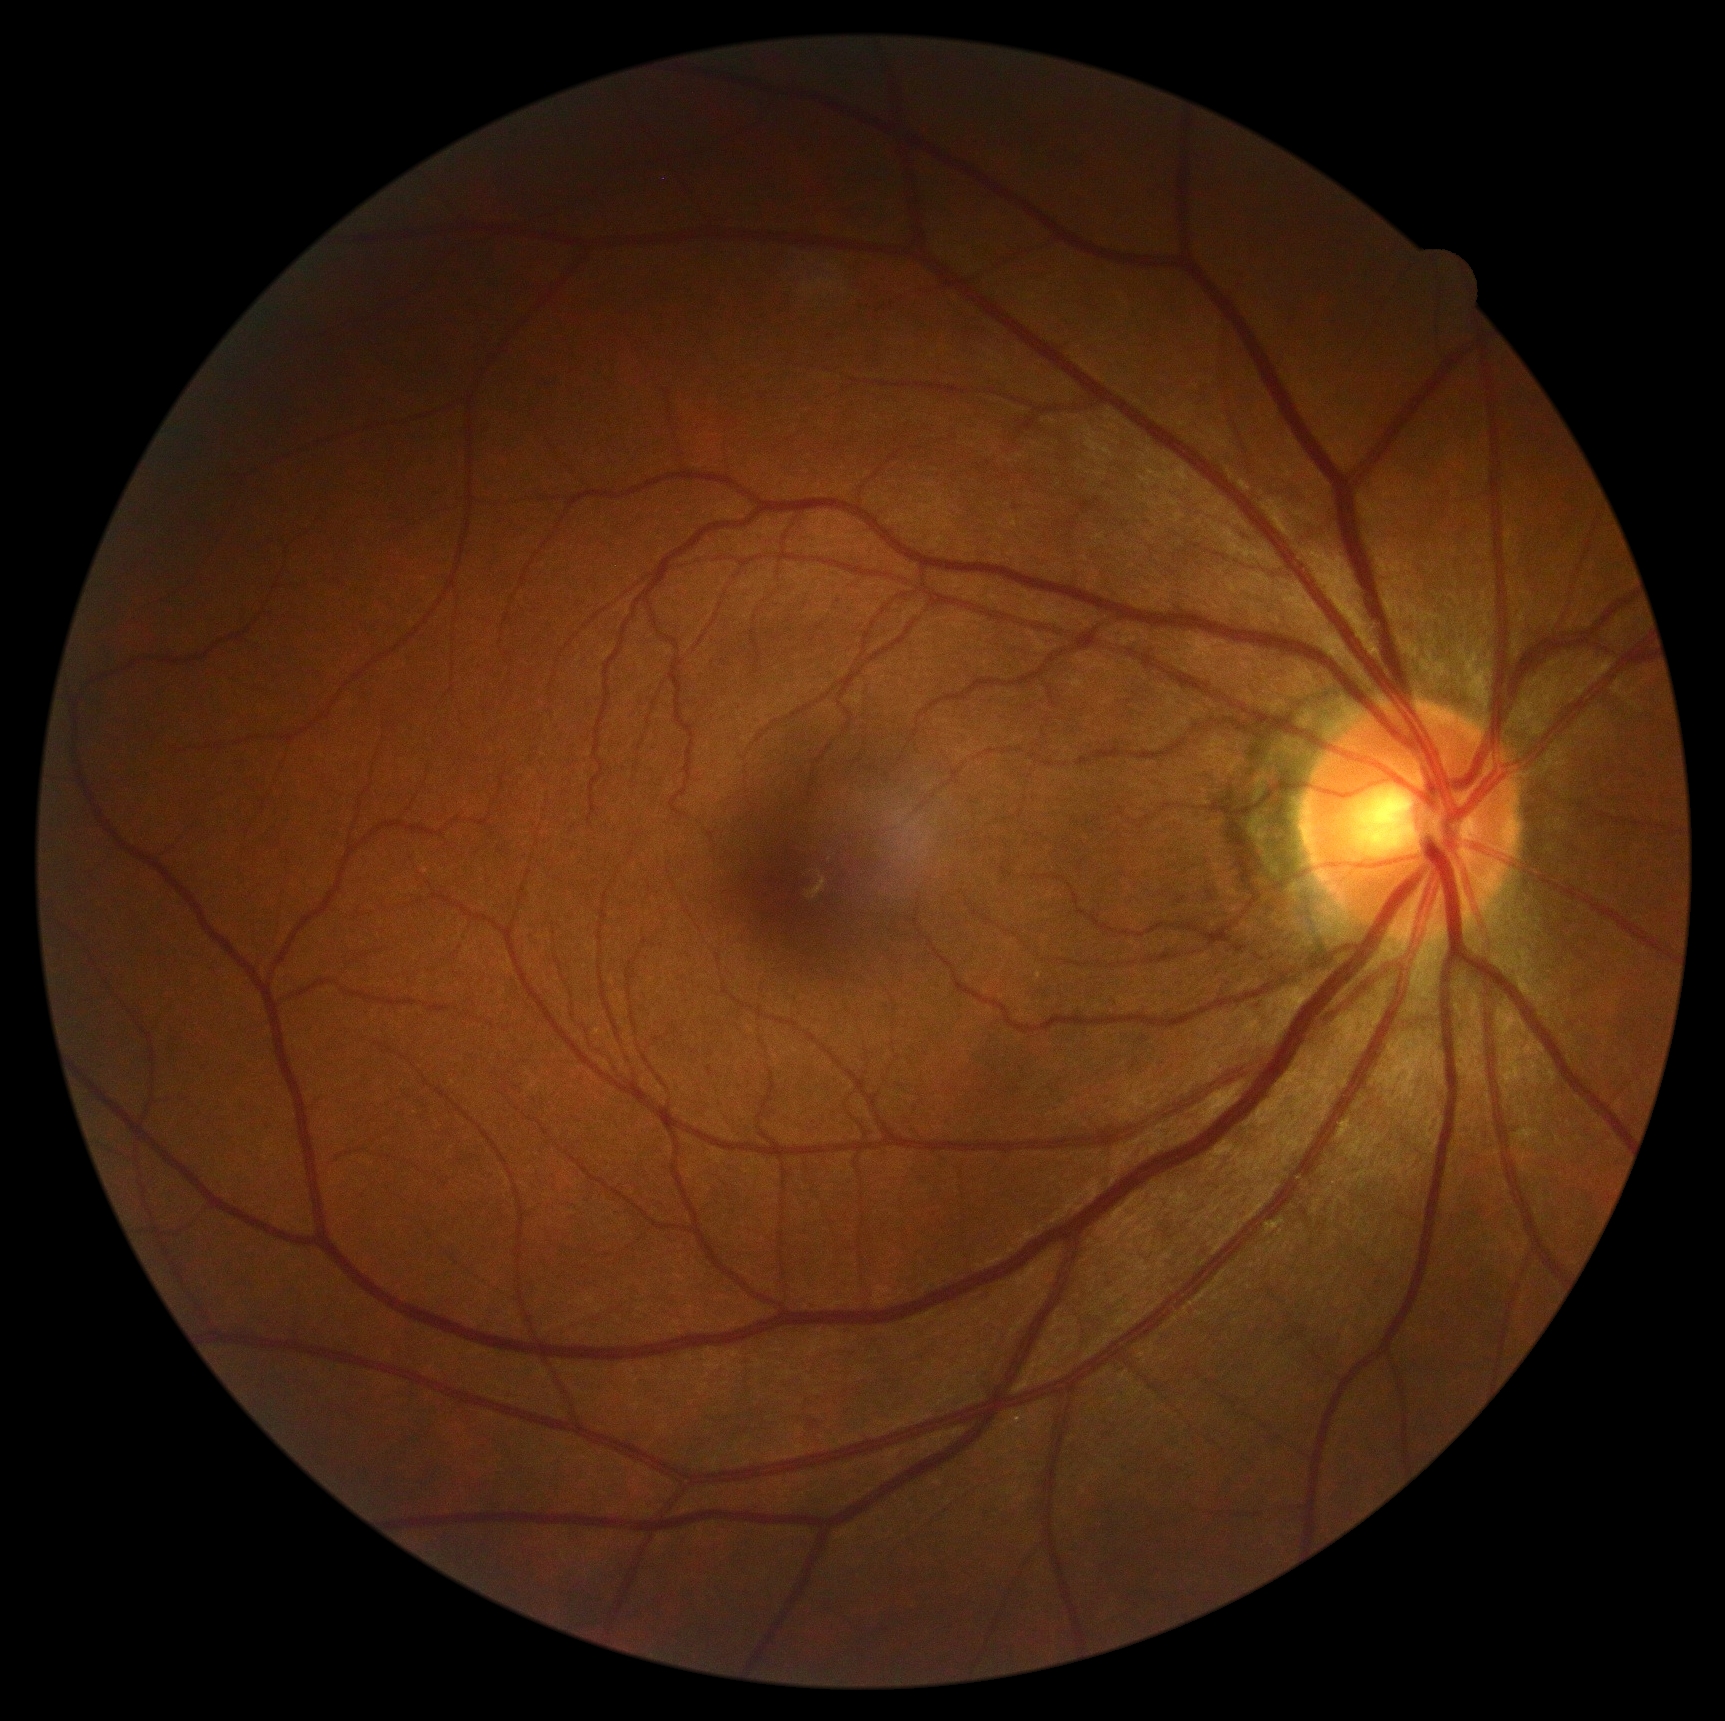

DR: grade 0 — no visible signs of diabetic retinopathy.